Wide-field fundus photograph from neonatal ROP screening: 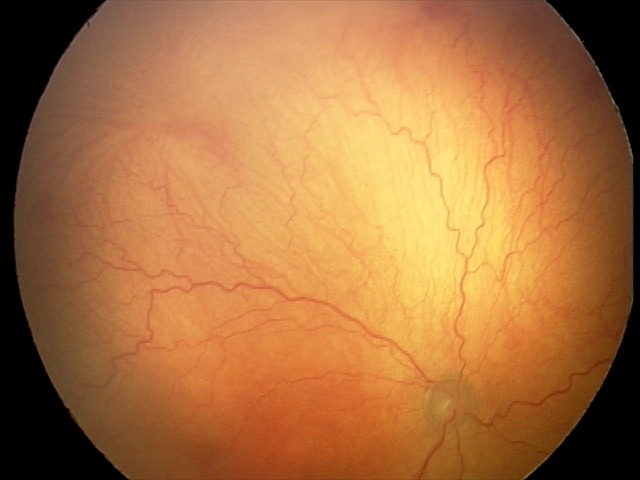
With plus disease. Screening examination consistent with aggressive retinopathy of prematurity.